45° FOV: 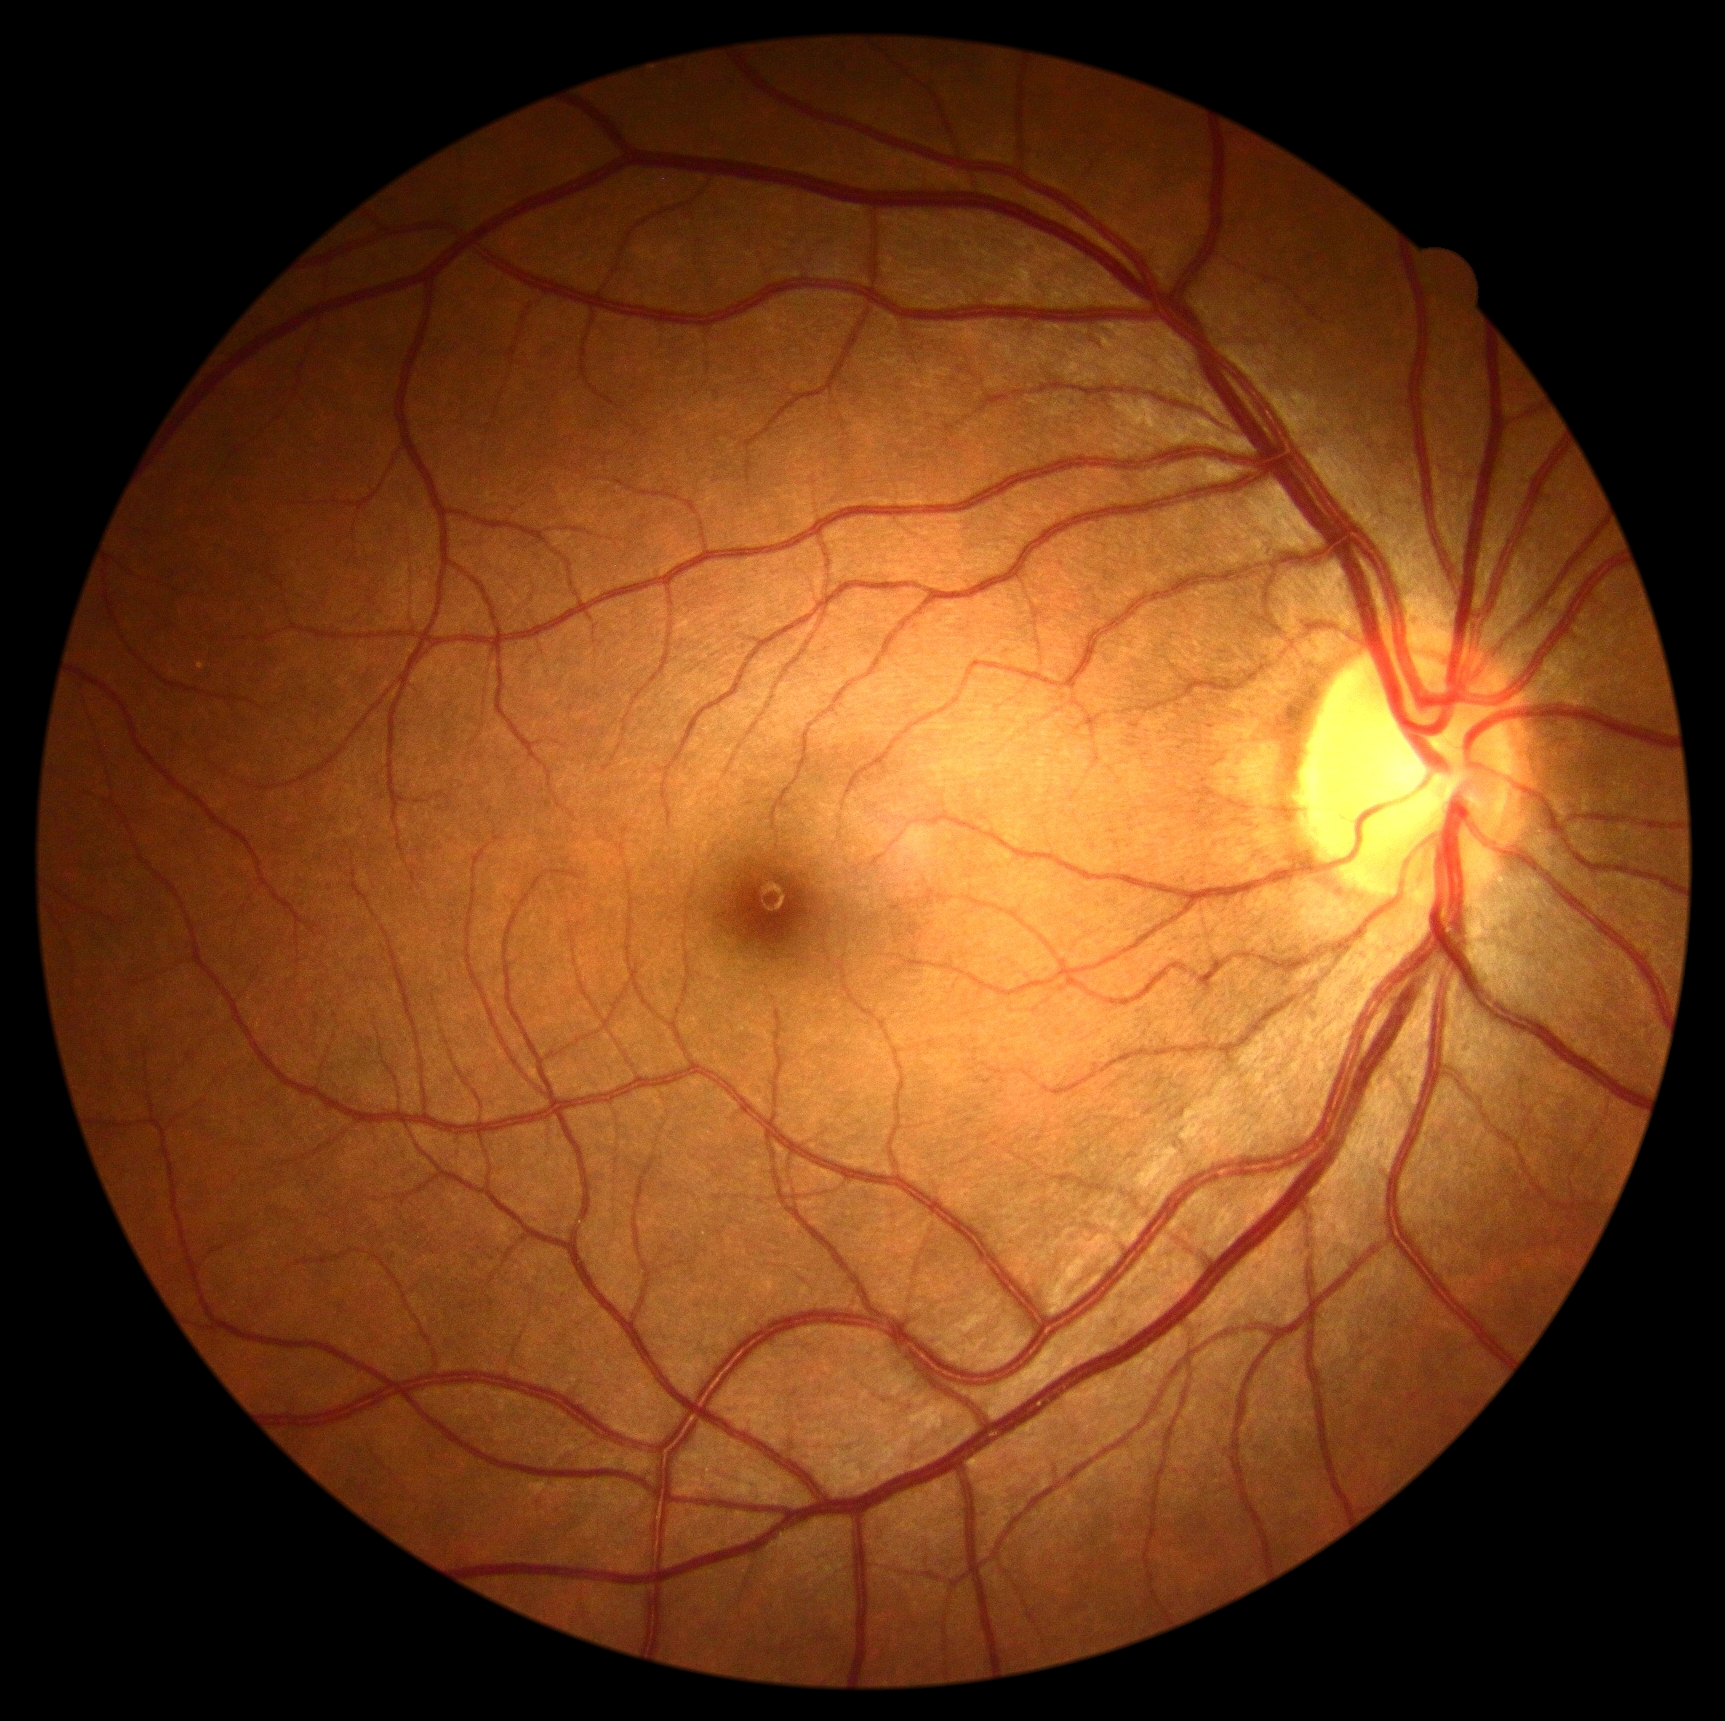 DR stage: no apparent diabetic retinopathy (grade 0). No DR findings.